Davis DR grading, posterior pole photograph, 848x848.
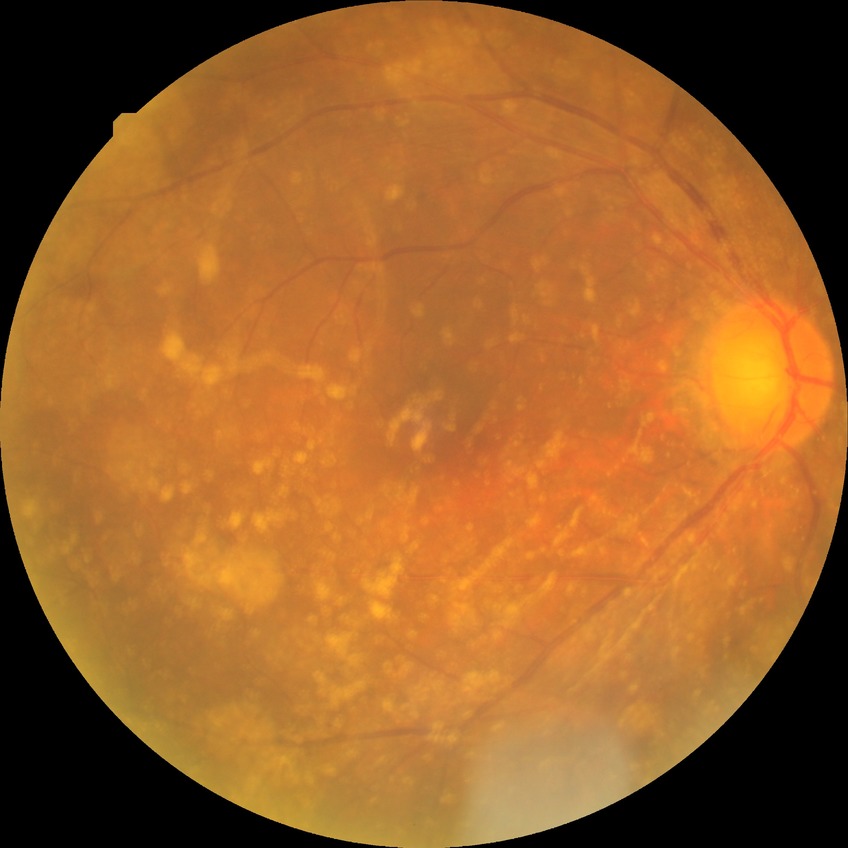 davis_grade: no diabetic retinopathy